Pediatric wide-field fundus photograph; acquired on the Clarity RetCam 3; 640x480px — 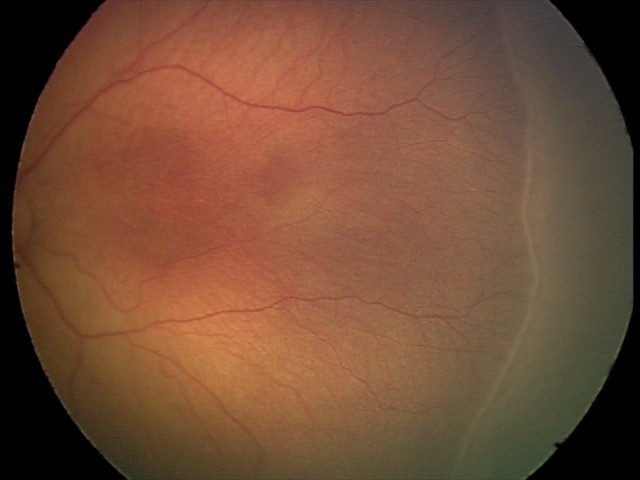
Screening series with retinopathy of prematurity (ROP) stage 2.